NIDEK AFC-230.
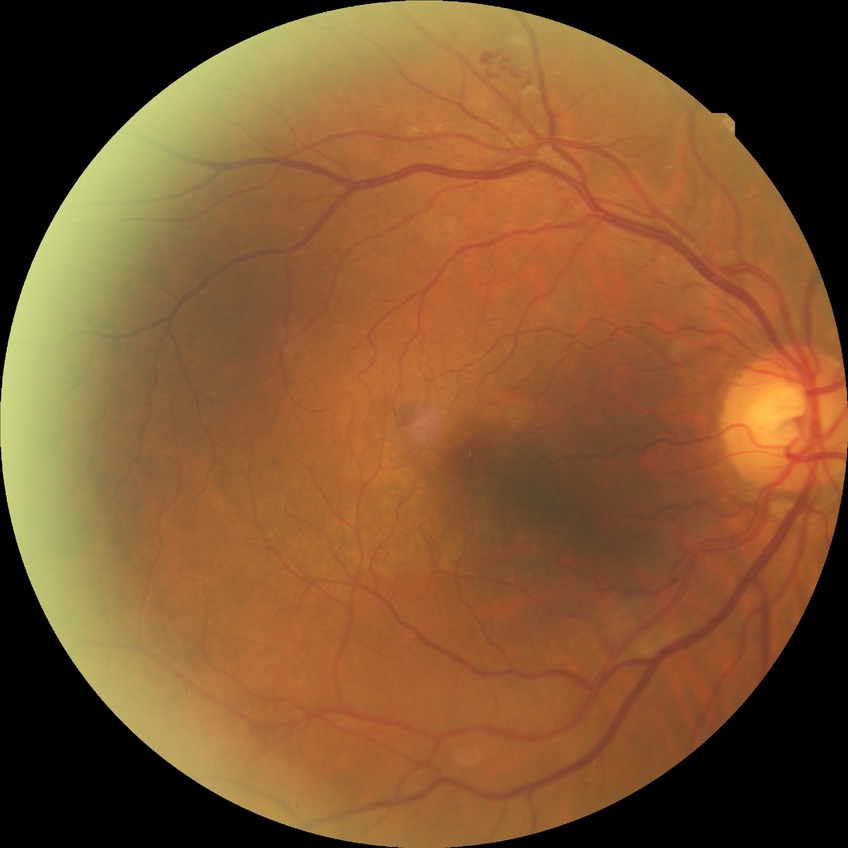
diabetic retinopathy (DR): proliferative diabetic retinopathy (PDR).